CFP; 1380x1382px
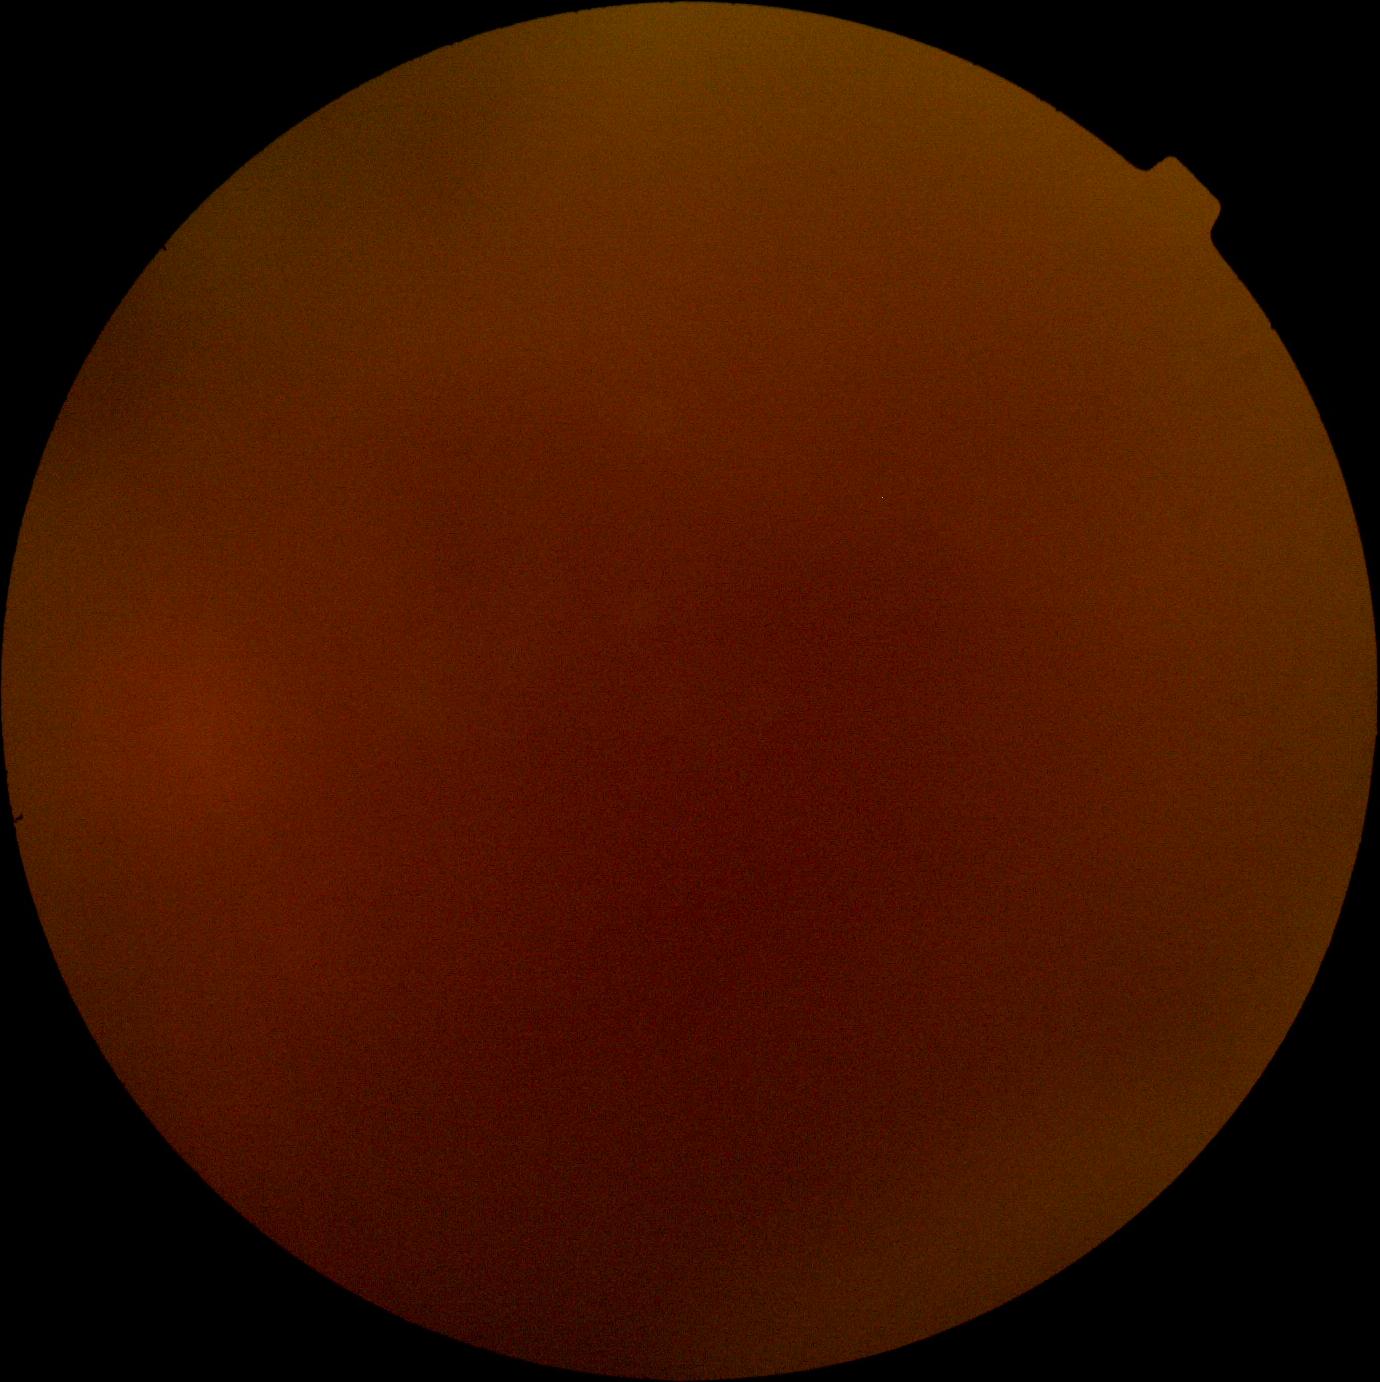 Diabetic retinopathy grade is ungradable due to poor image quality.